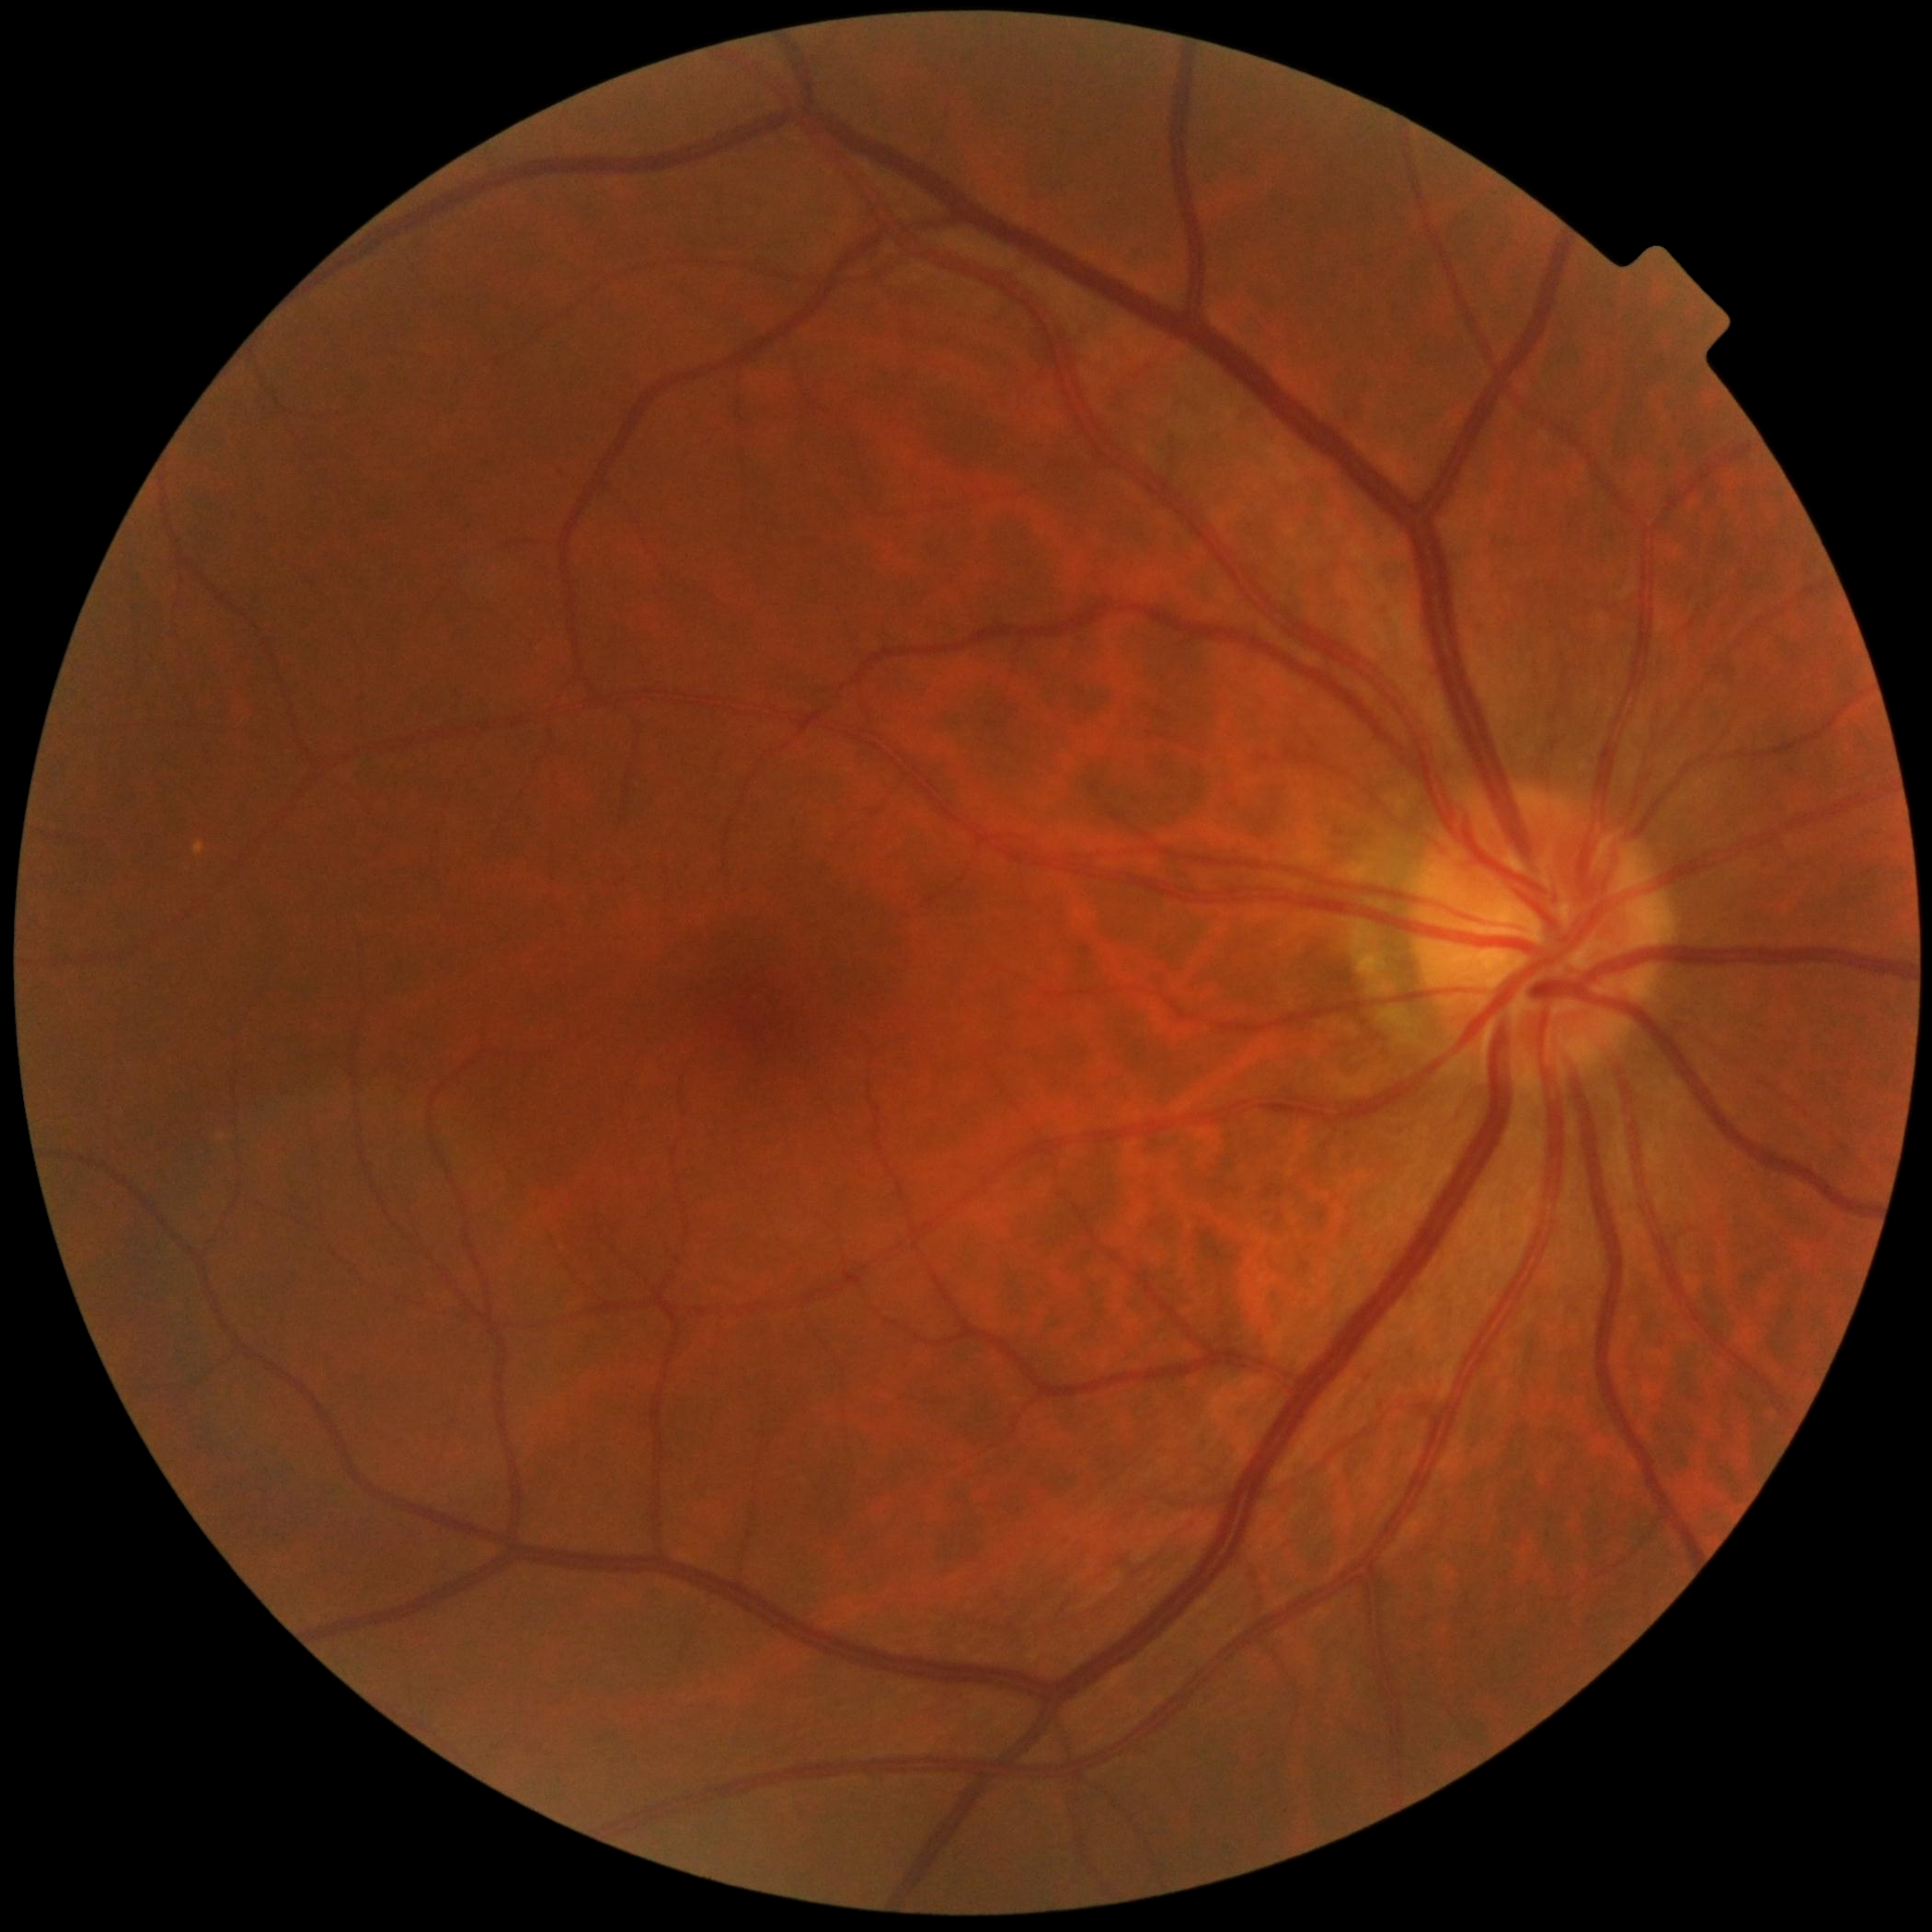 DR grade is 0 (no apparent retinopathy). No apparent diabetic retinopathy.